Diabetic retinopathy graded by the modified Davis classification — 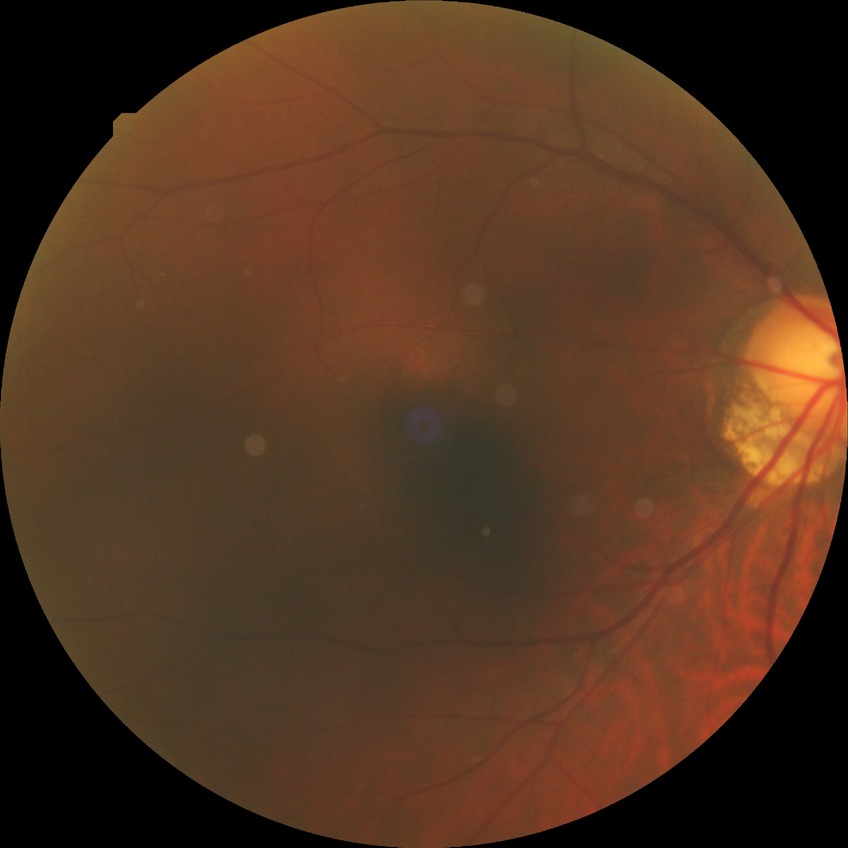

{"davis_grade": "no diabetic retinopathy"}